Image size 1380x1382 — 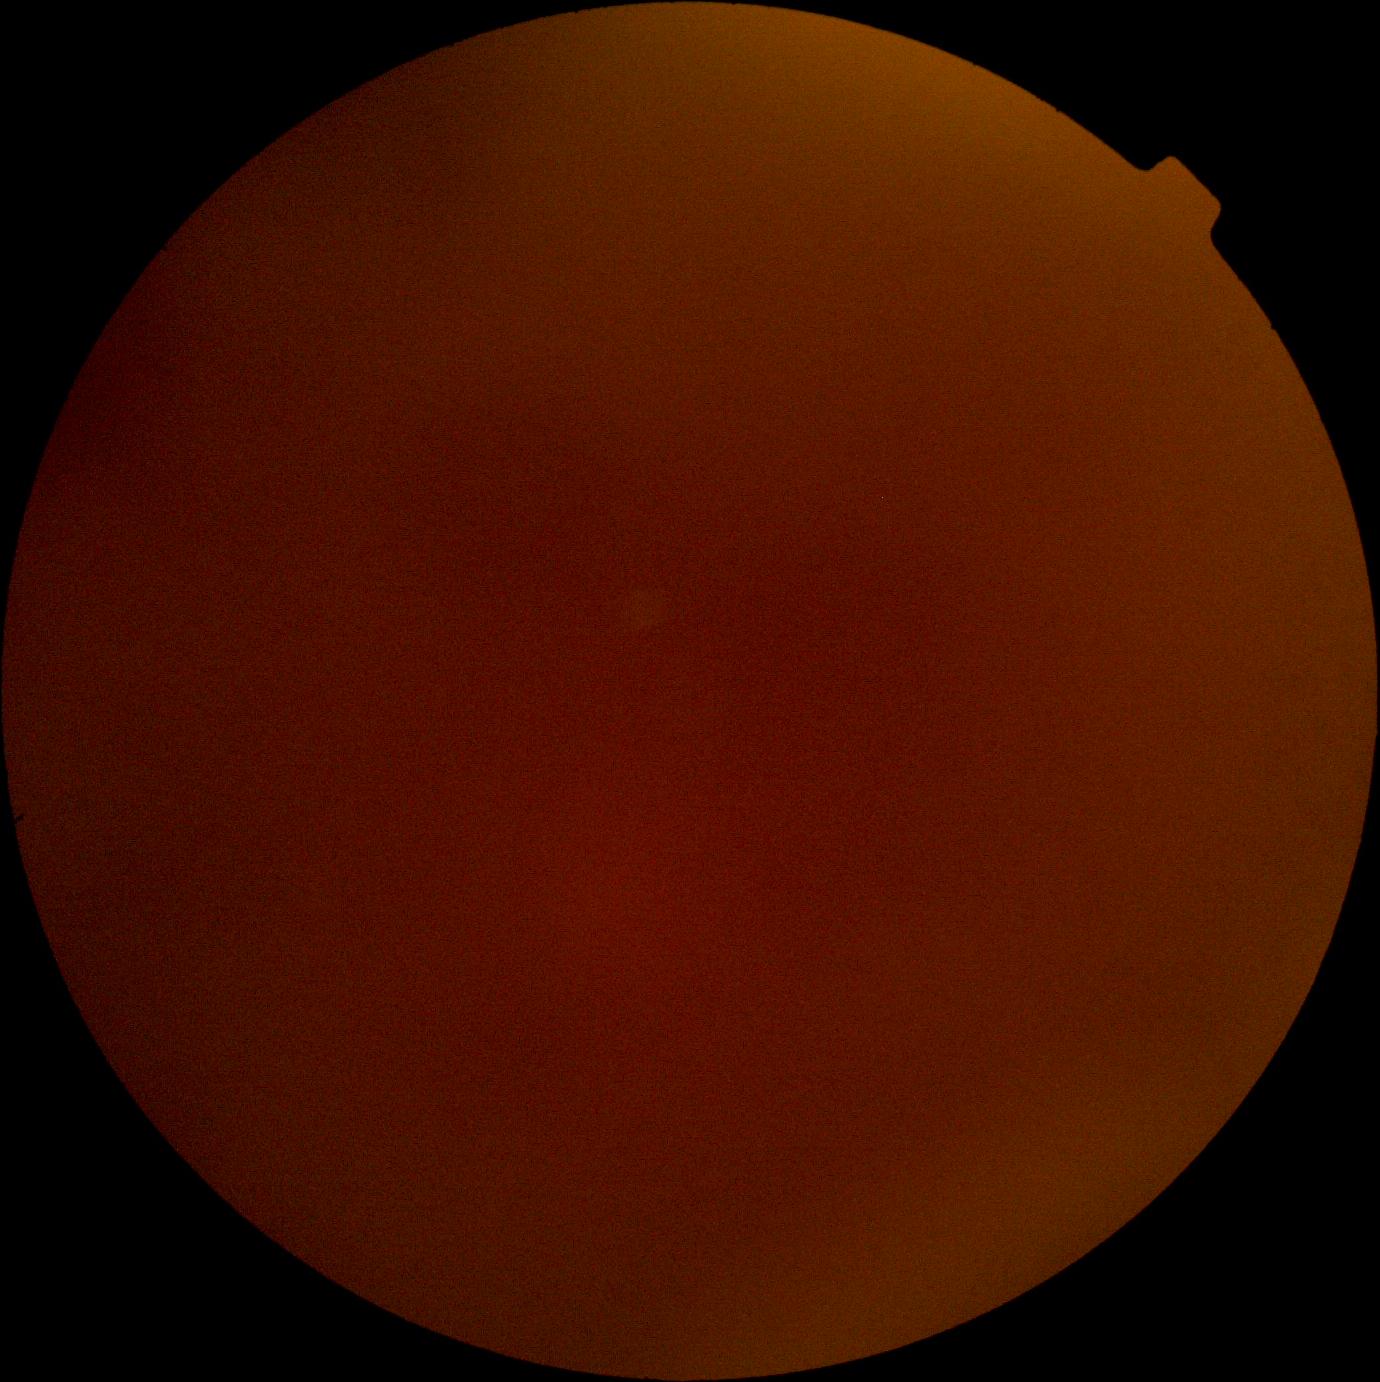
Diabetic retinopathy (DR): ungradable.